Posterior pole photograph · NIDEK AFC-230 fundus camera · 45° field of view.
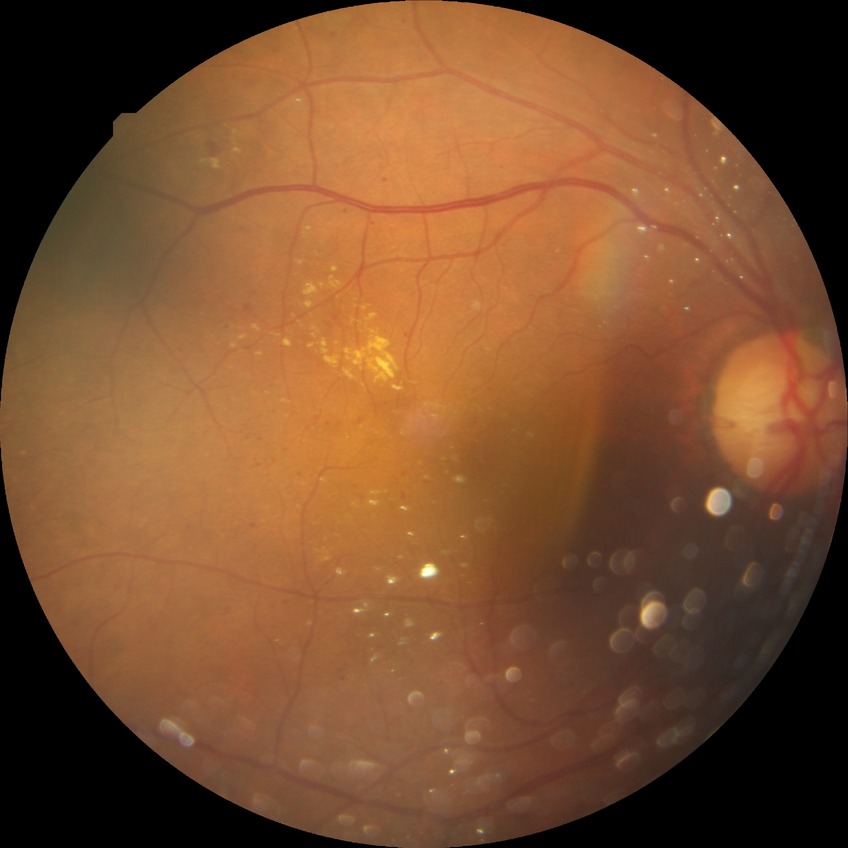 Diabetic retinopathy (DR): SDR (simple diabetic retinopathy). Disease class: non-proliferative diabetic retinopathy.